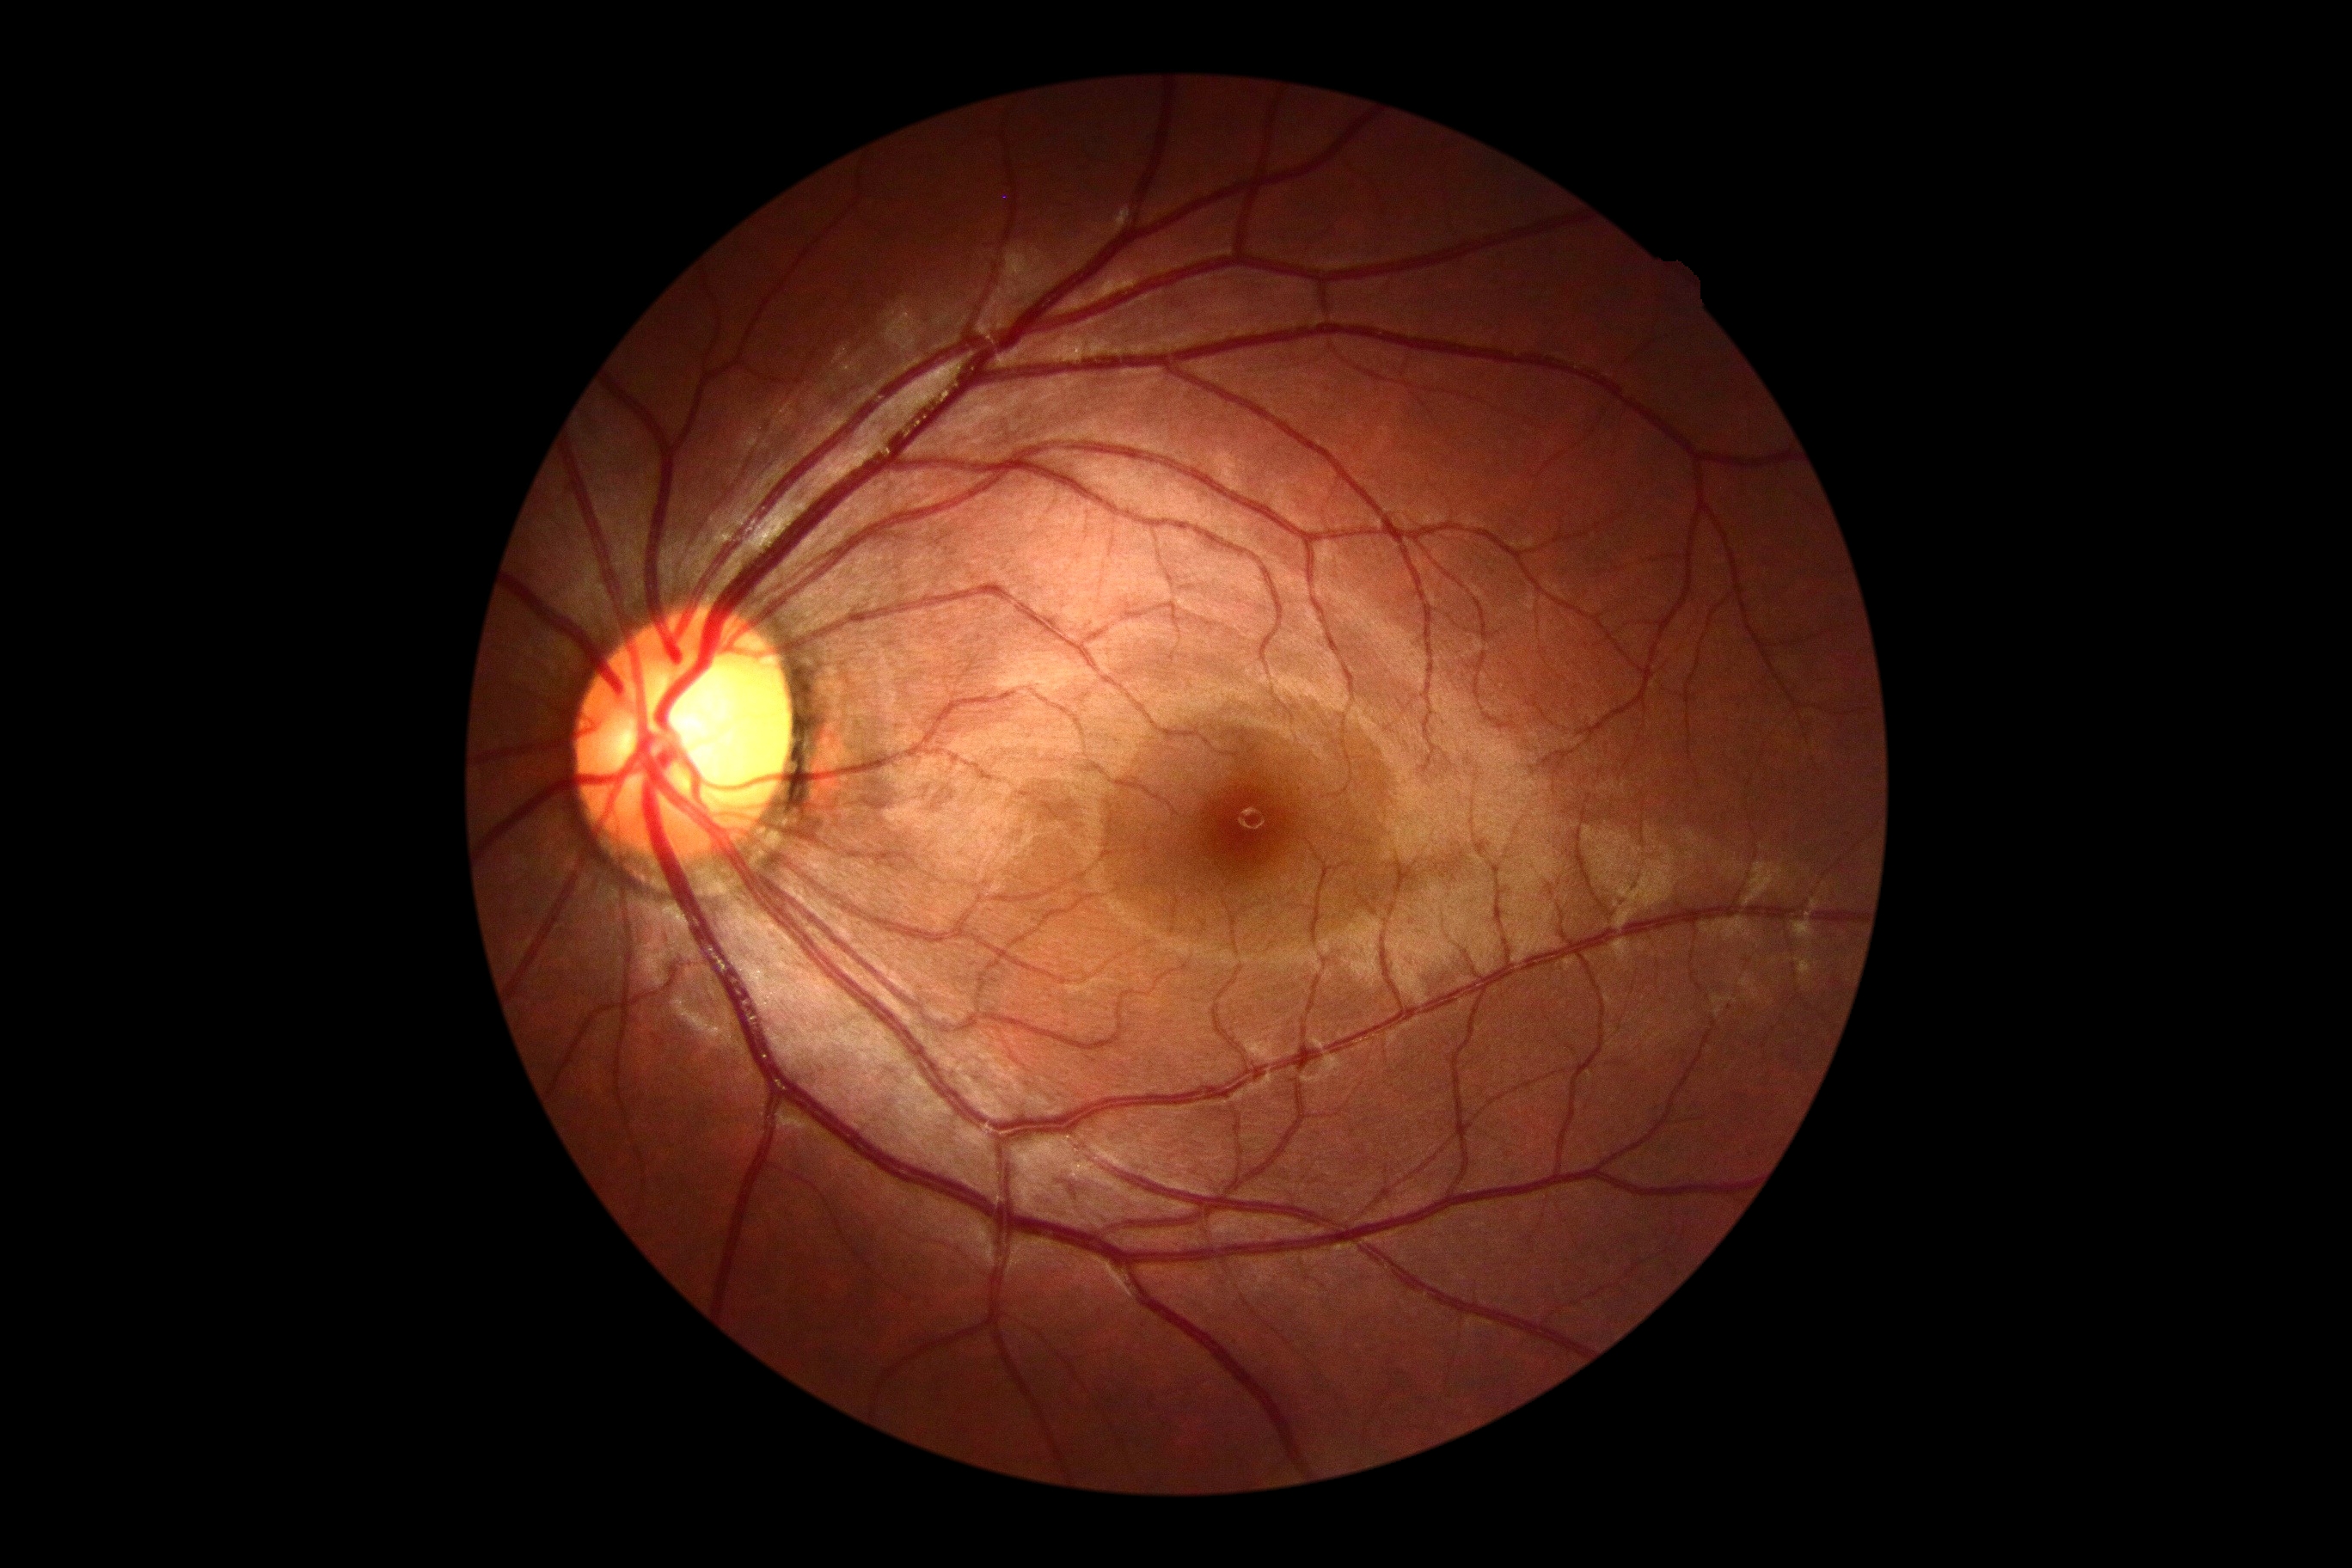

Diabetic retinopathy: 0. No diabetic retinal disease findings.